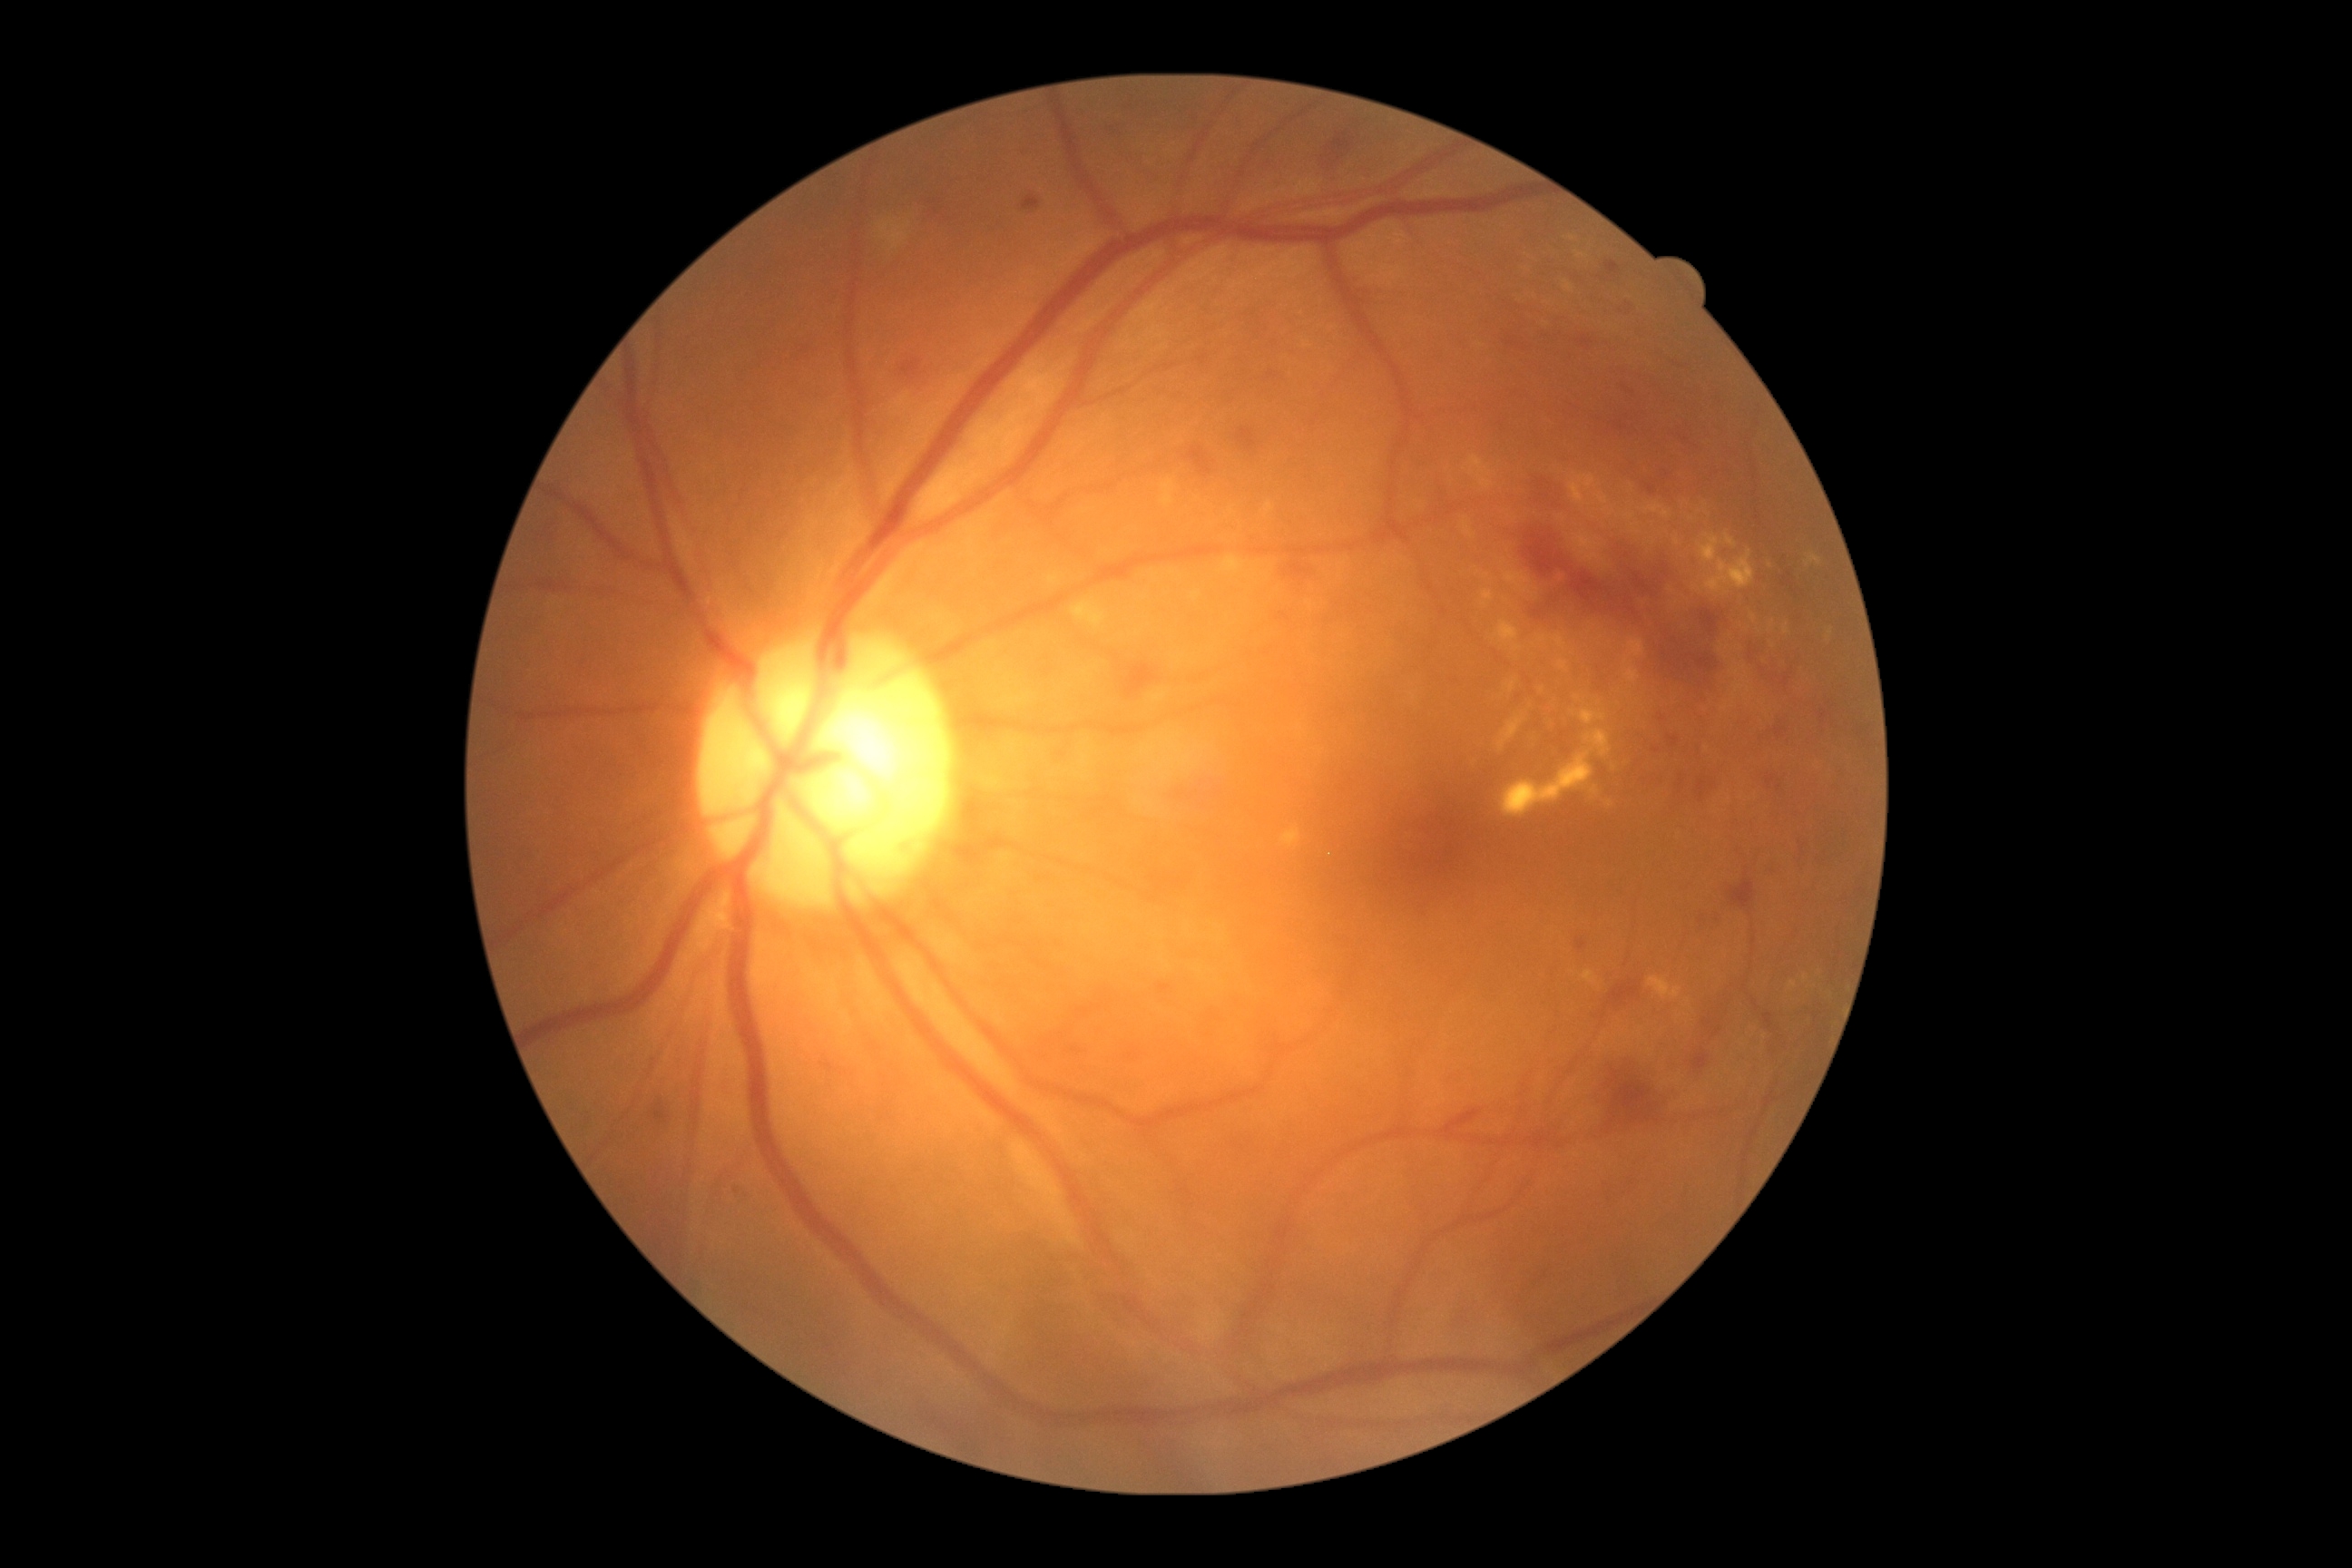

DR grade is moderate non-proliferative diabetic retinopathy (2)
Selected lesions:
EXs (partial): (1596,493,1609,505); (1553,634,1565,649); (1538,636,1549,643); (1574,531,1609,571); (1698,534,1720,564); (1603,507,1614,518); (1498,718,1524,750); (1482,591,1494,609); (1732,681,1750,700); (1222,556,1246,574); (1750,614,1758,622); (1558,662,1567,671); (1625,513,1636,522); (1464,456,1493,489)
Small EXs near 1677/541; 1772/625; 1721/648; 1331/856; 1232/511; 1627/661